Infant wide-field fundus photograph
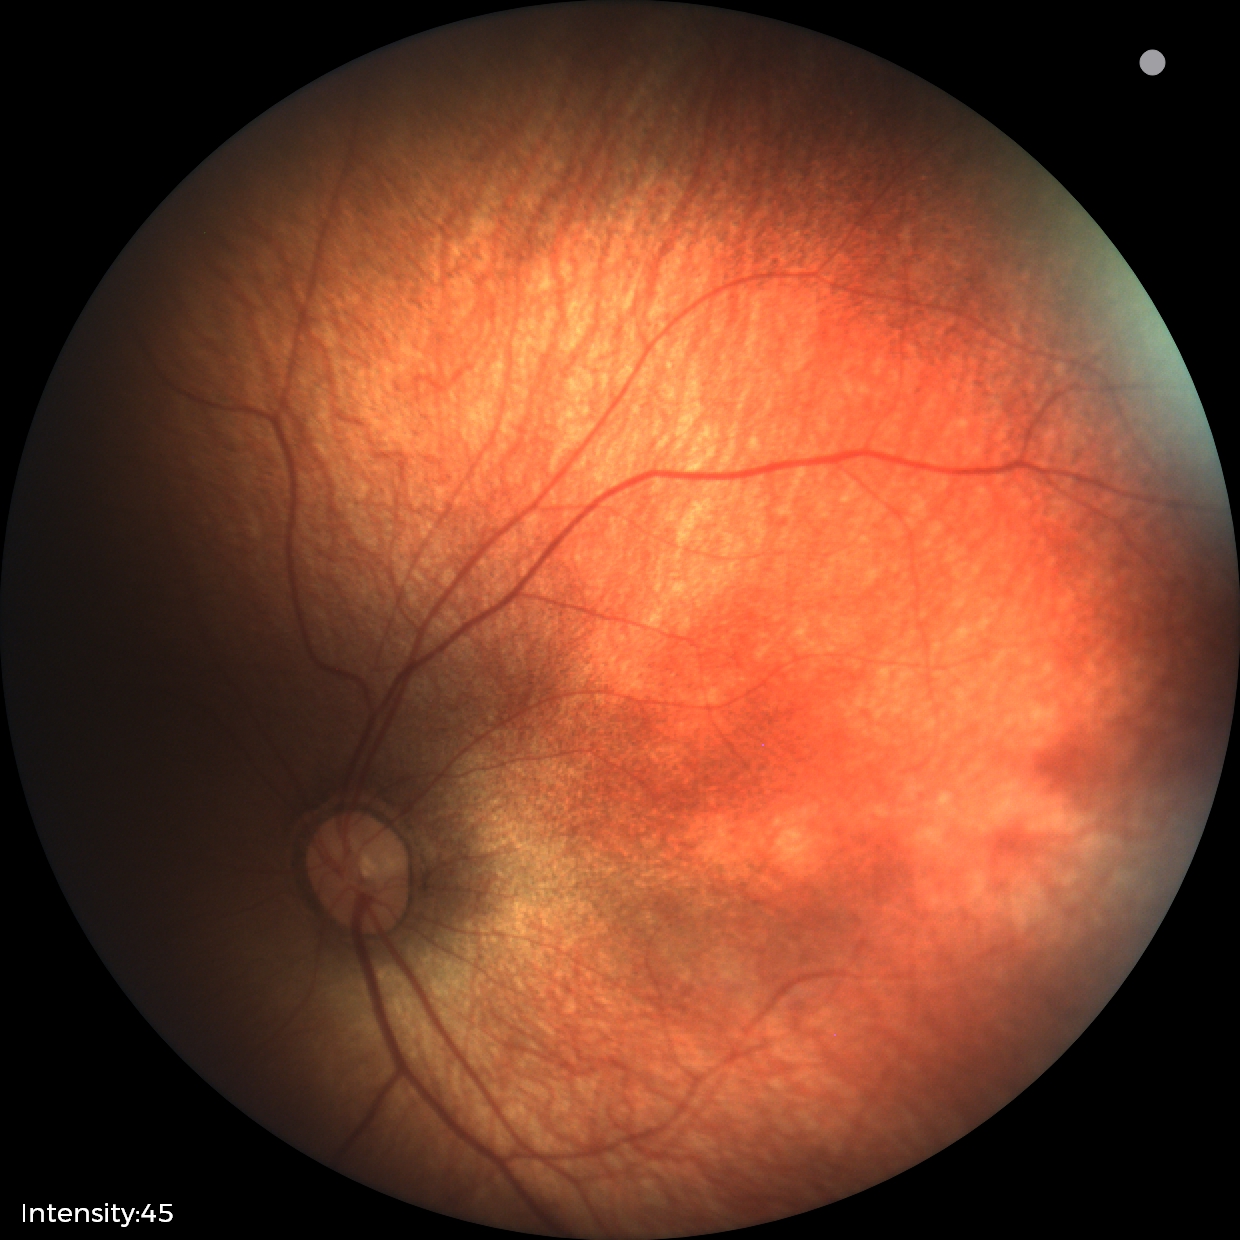 Assessment: normal retinal appearance.